Retinal fundus photograph · 45° FOV.
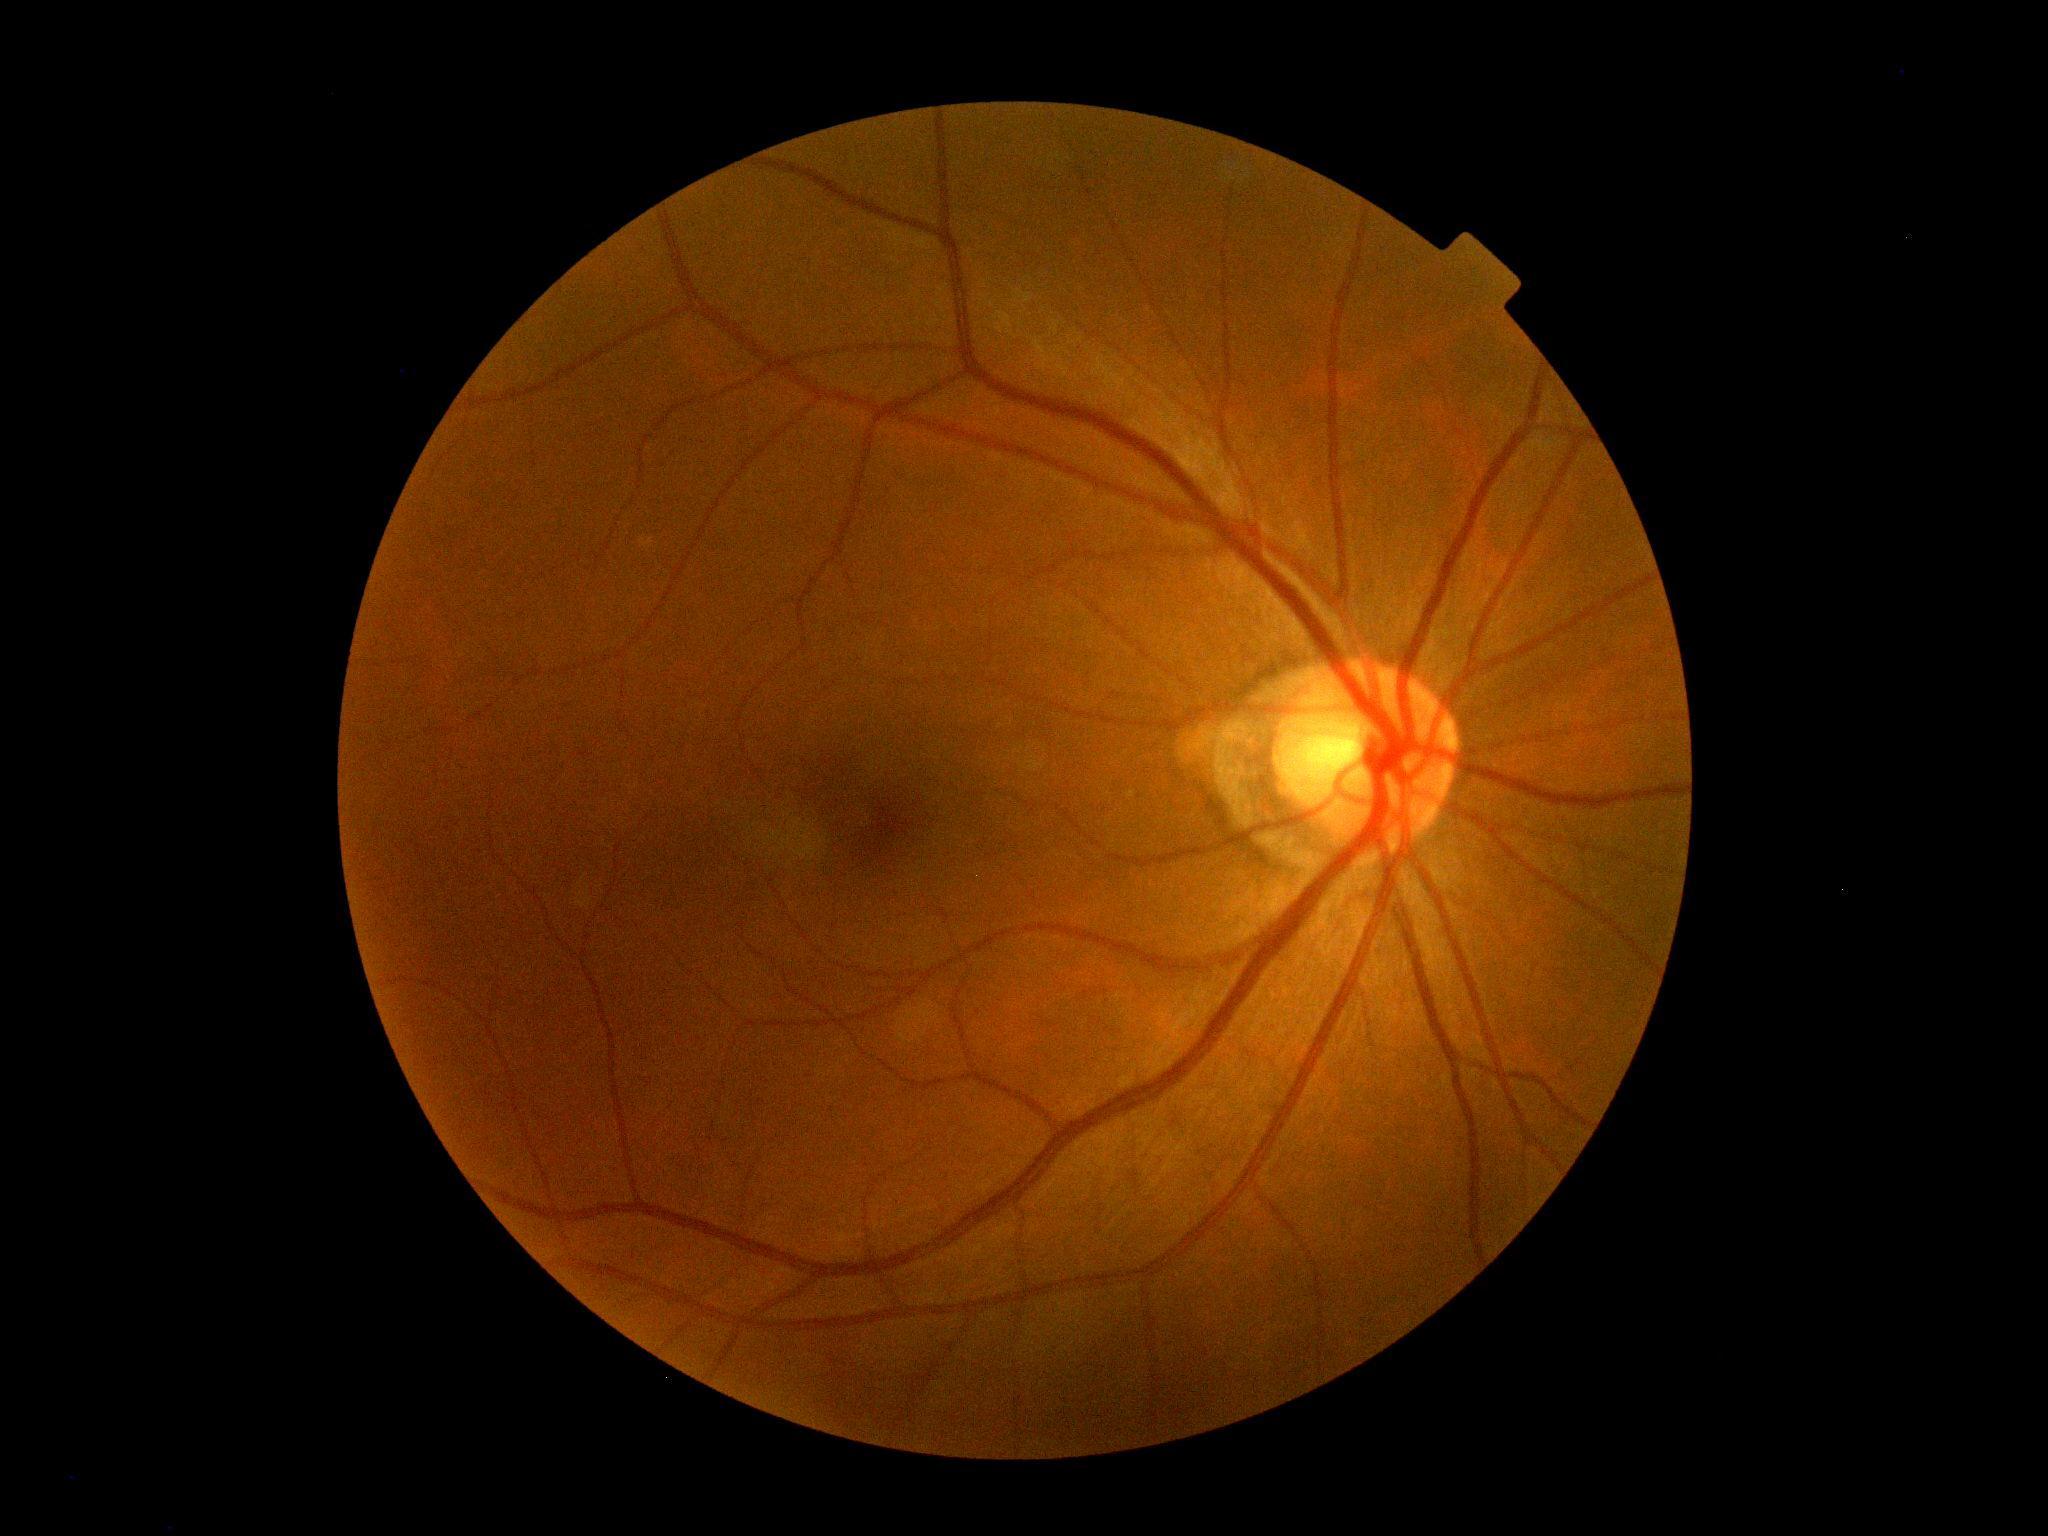 Diabetic retinopathy severity is grade 0 — no visible signs of diabetic retinopathy. No diabetic retinal disease findings.